Wide-field fundus photograph of an infant — 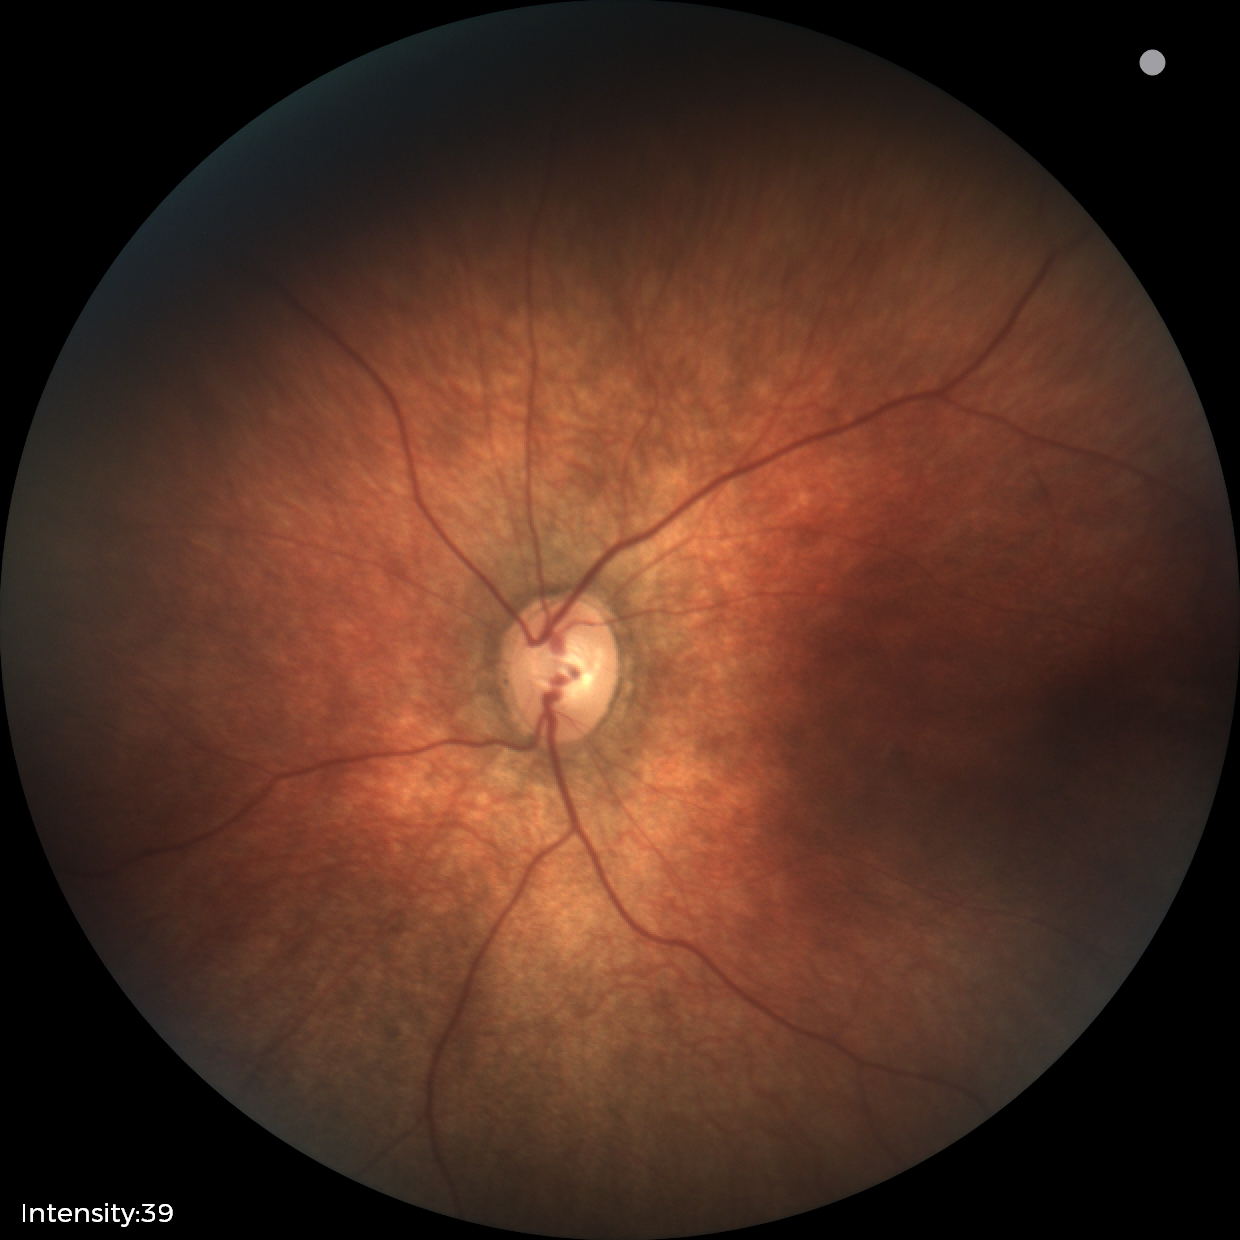
Screening examination with no abnormal retinal findings.